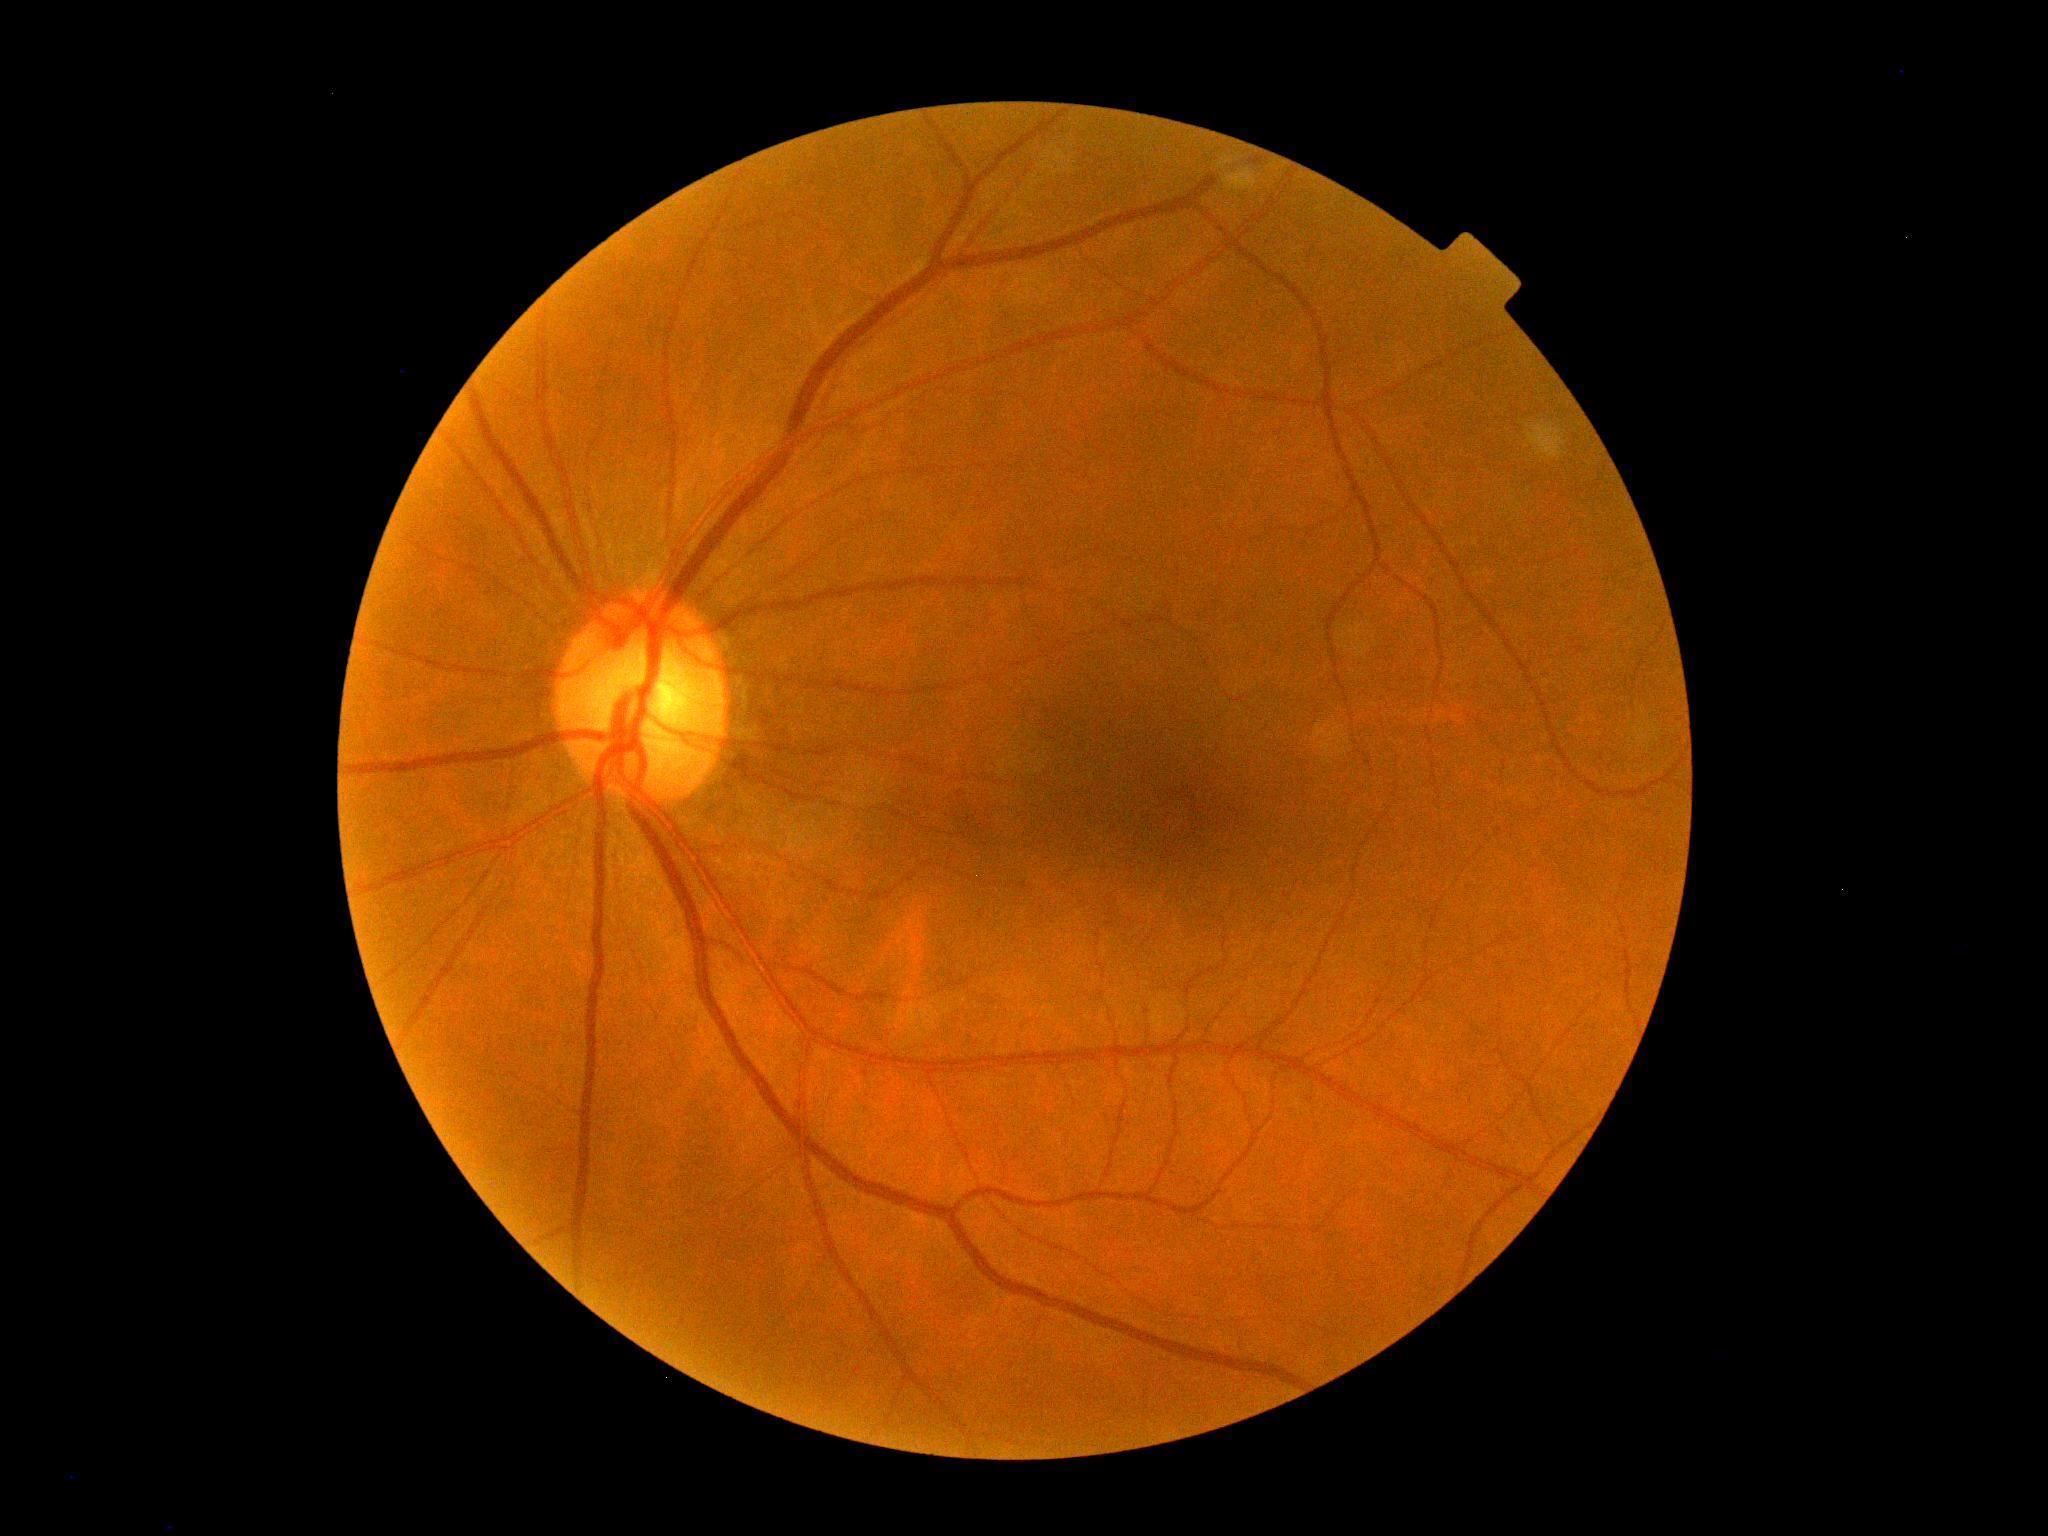 DR severity is no apparent diabetic retinopathy (grade 0).
No diabetic retinal disease findings.